2212x1659px · 45° field of view — 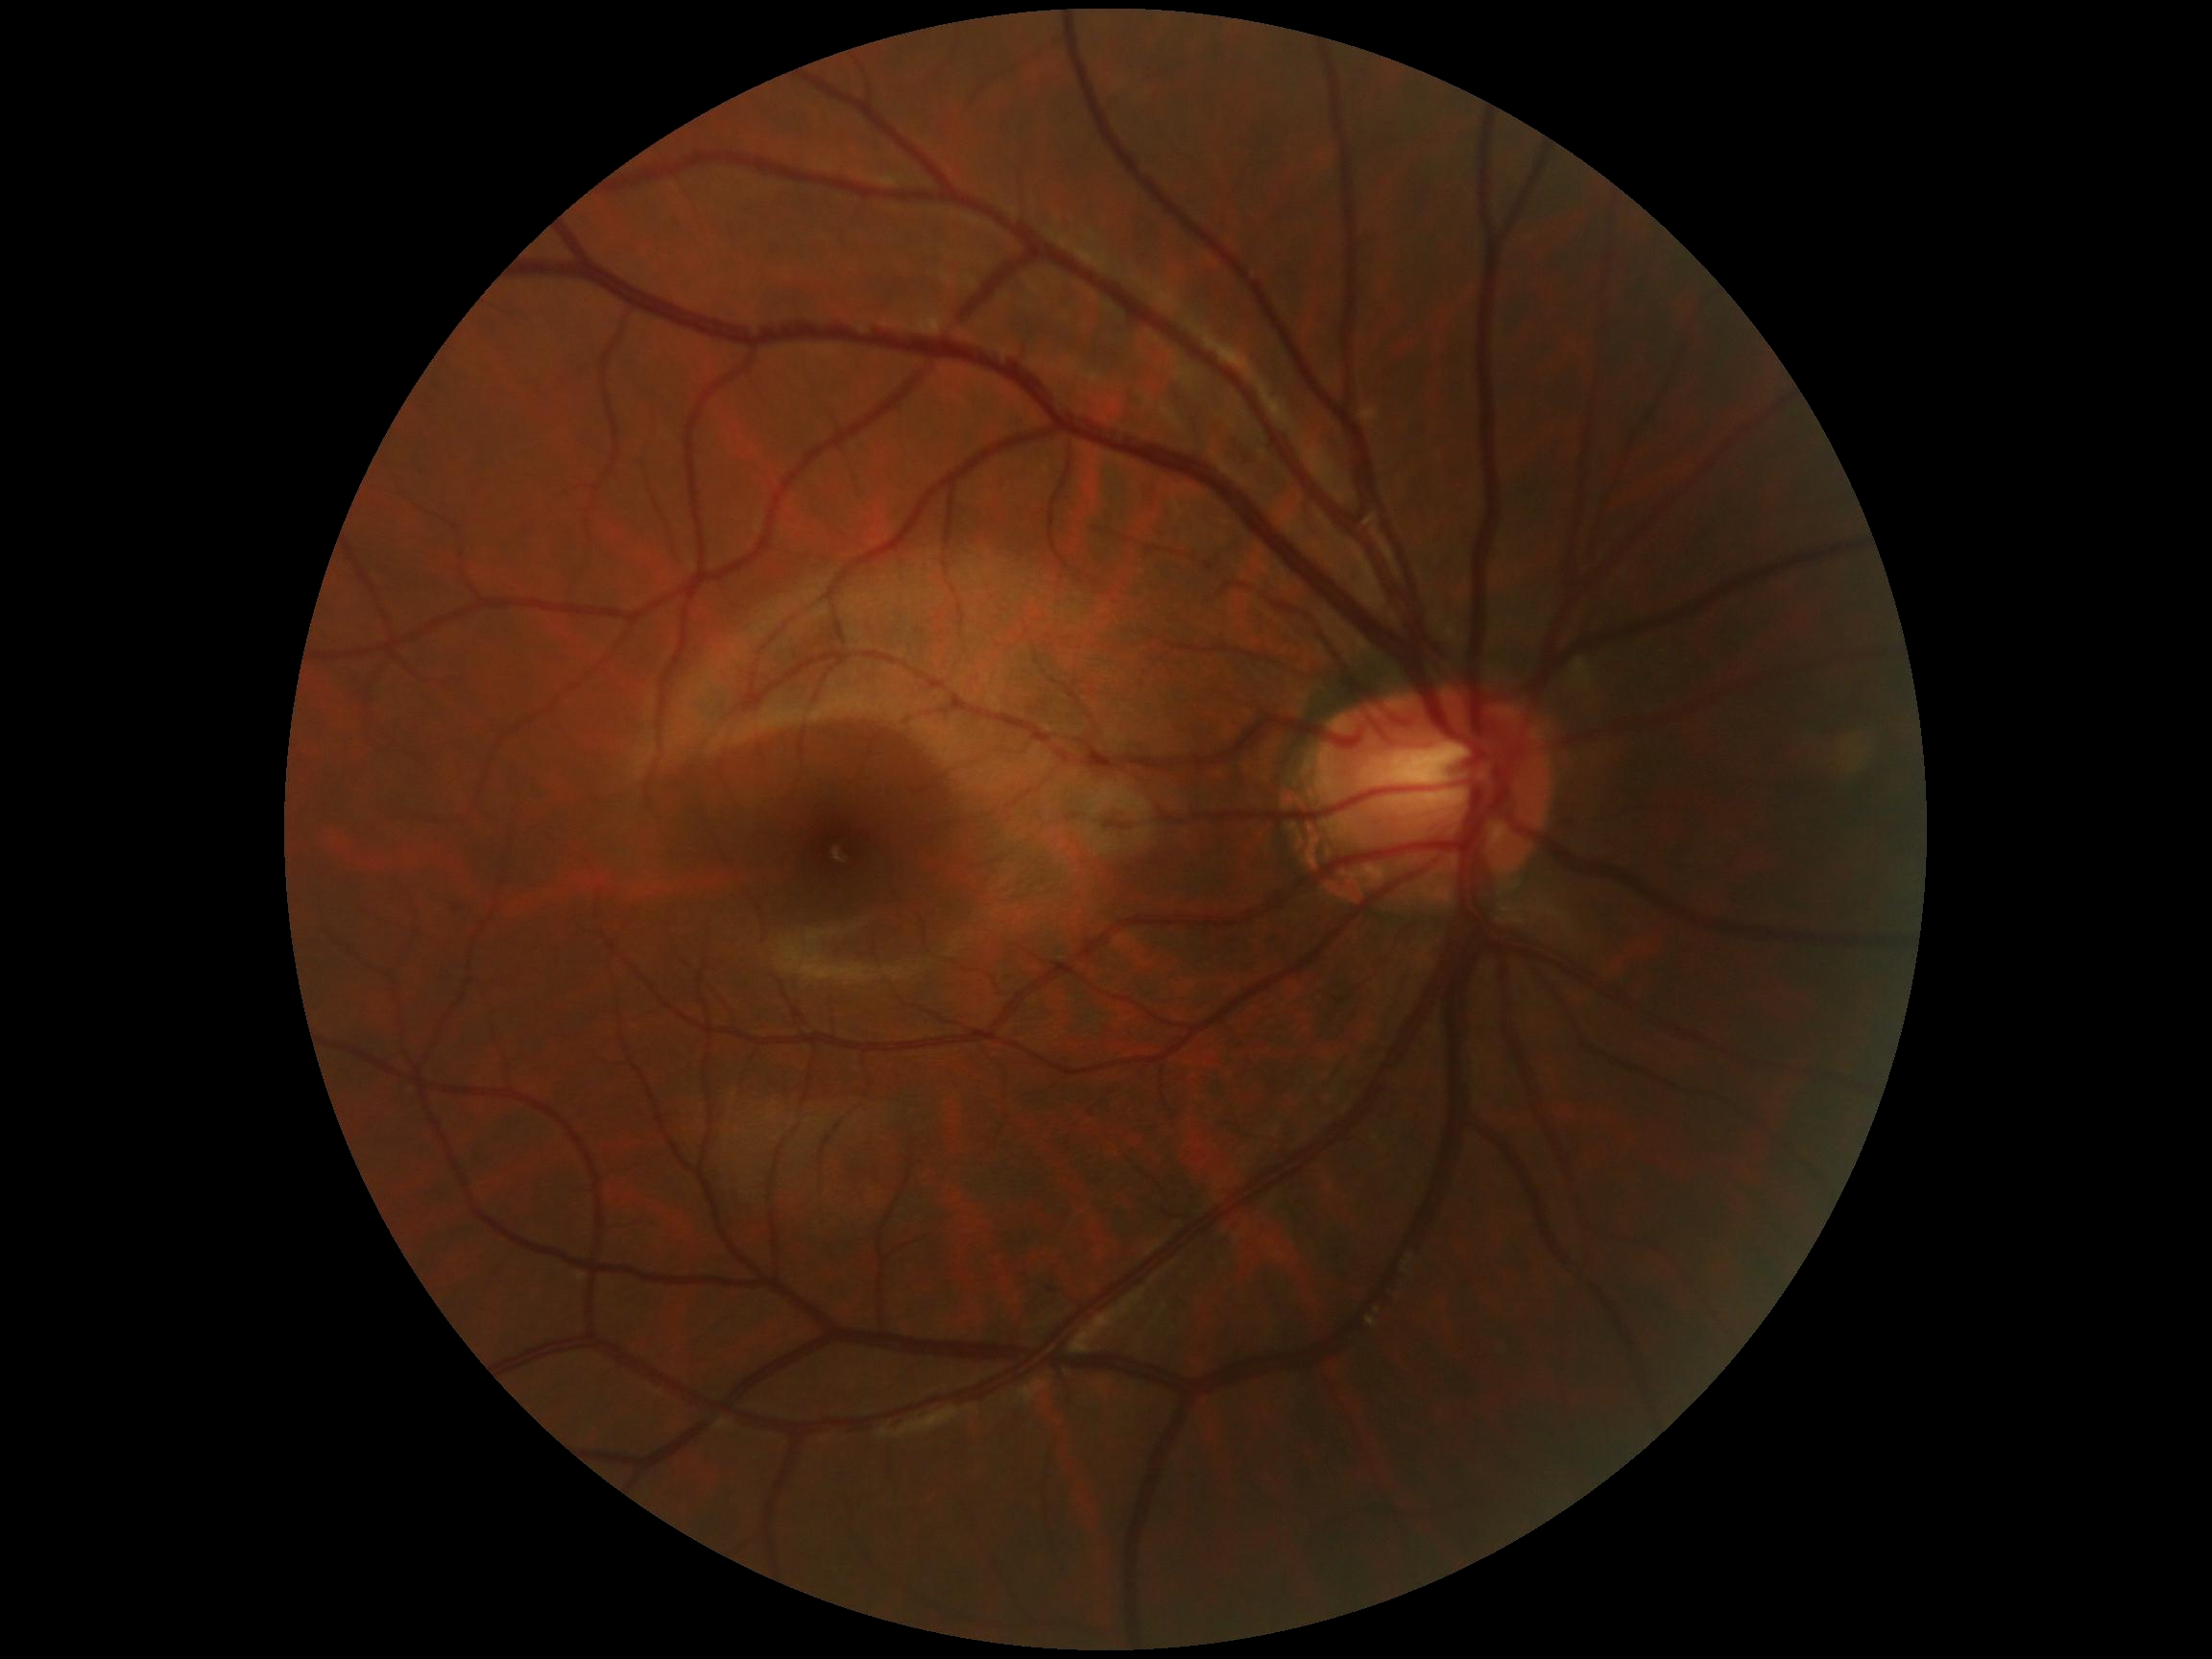

Diabetic retinopathy (DR): grade 0. No DR findings.